Fundus photo · 50-degree field of view.
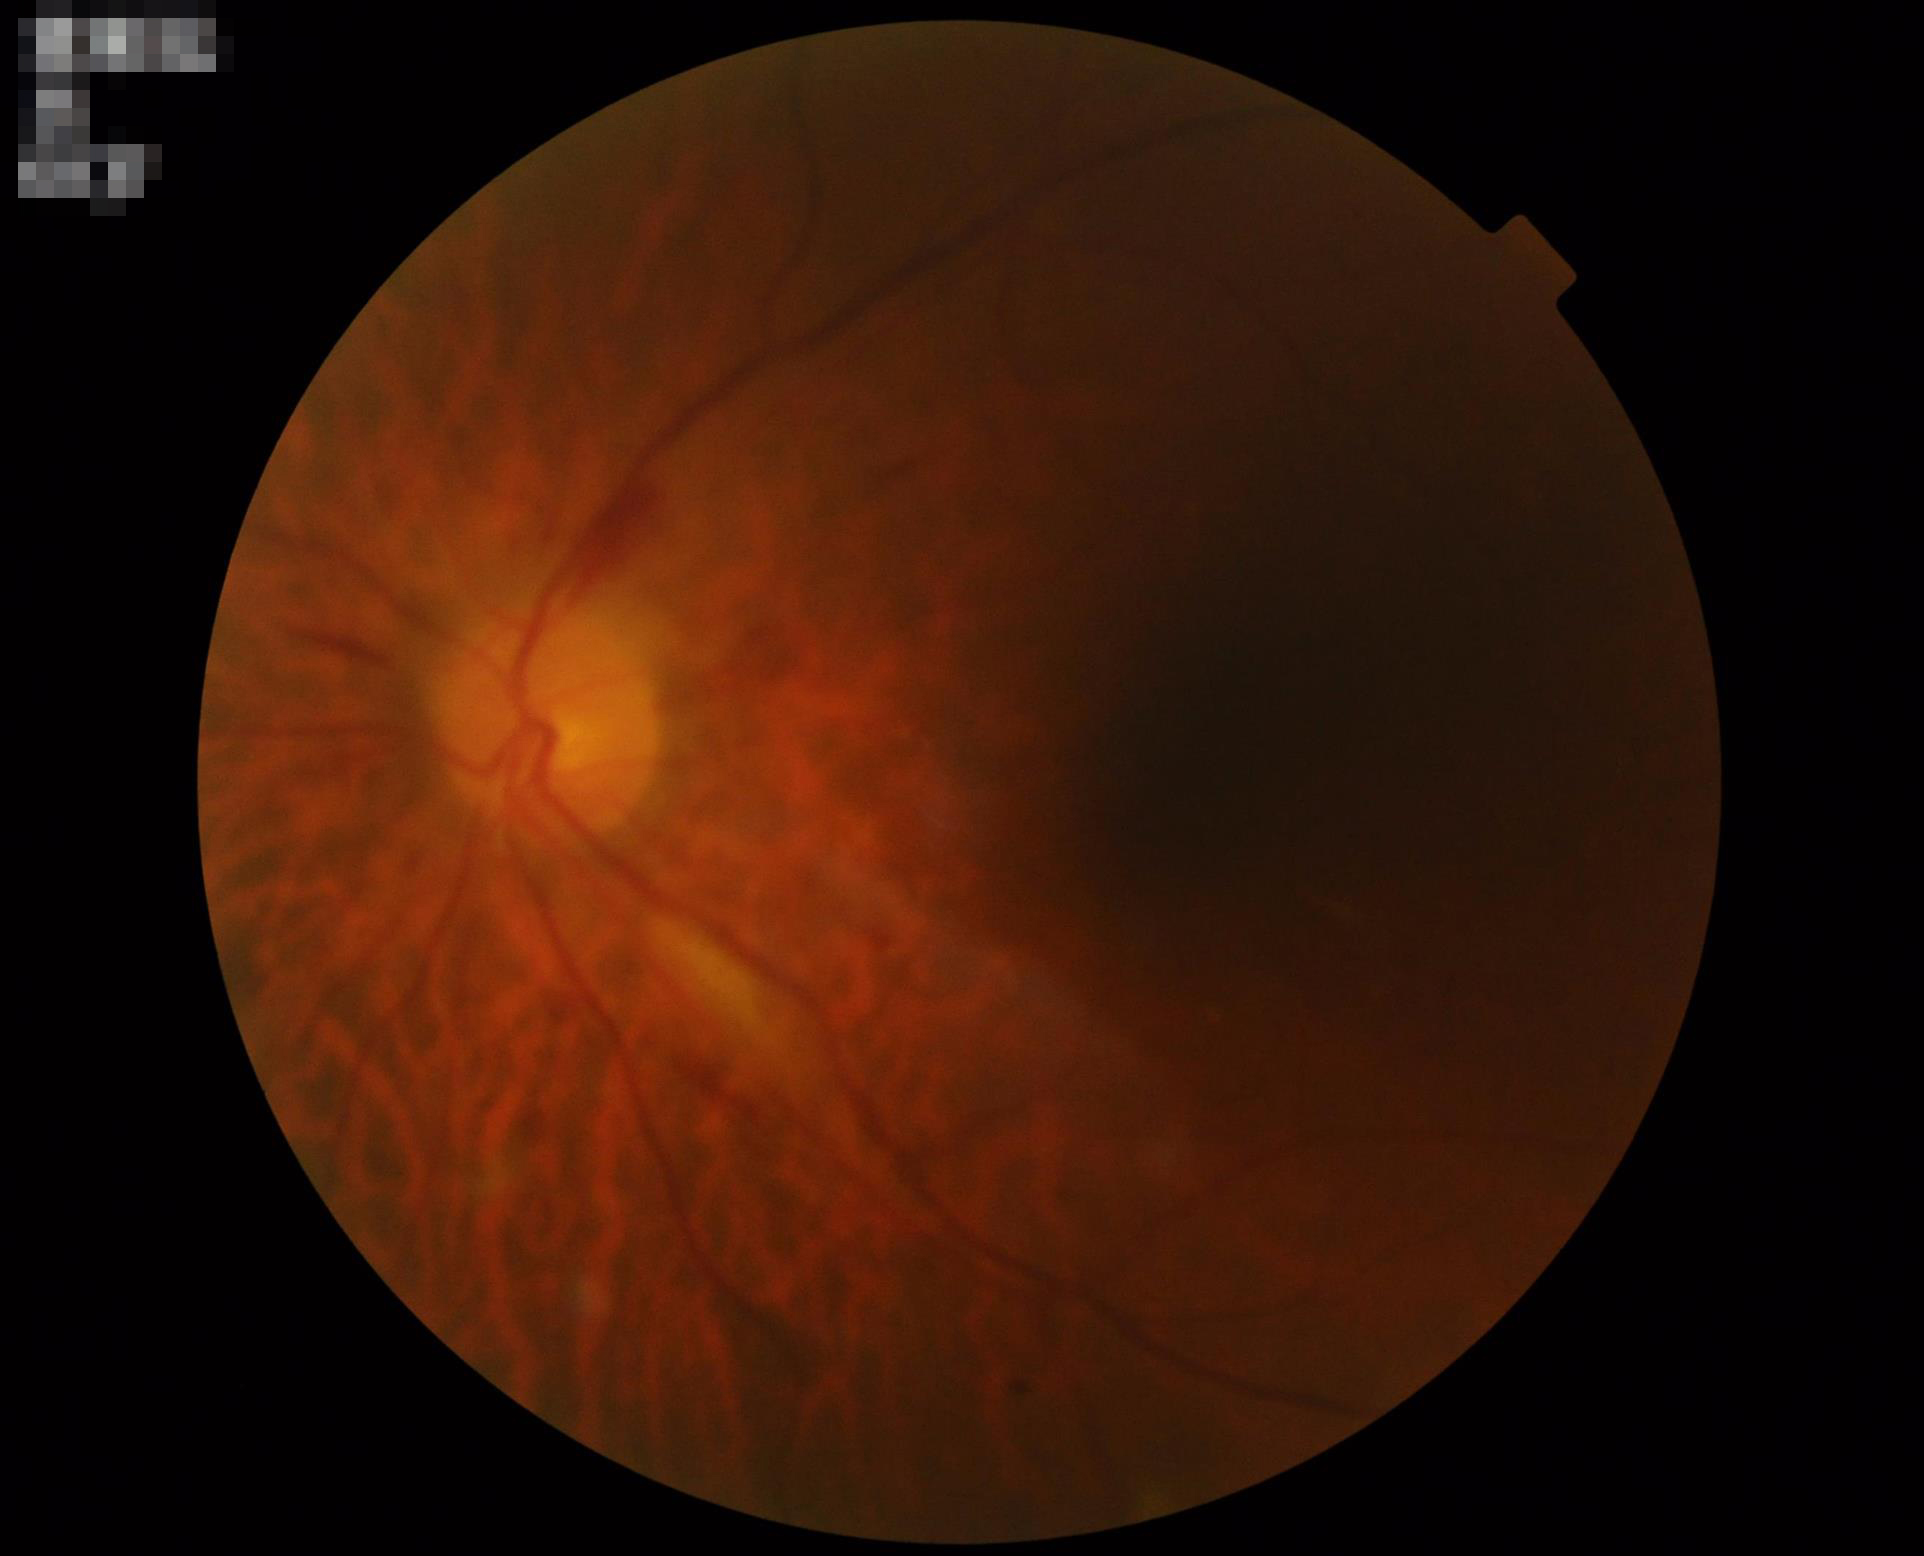

Out of focus; structures are indistinct.
Poor illumination with uneven exposure.
Overall quality is poor; the image is difficult to grade.
Adequate contrast for distinguishing structures.